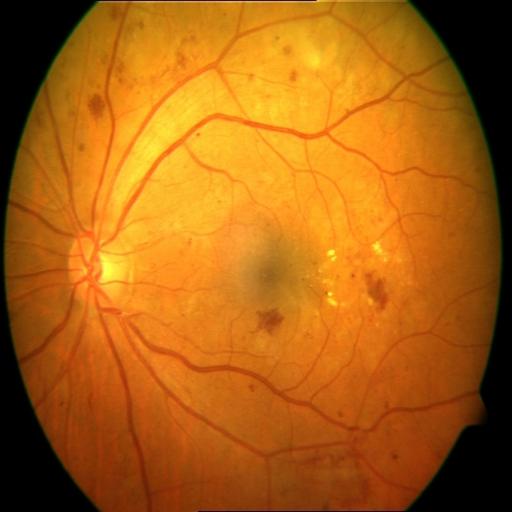 Diagnoses: hemorrhagic retinopathy; microaneurysms.